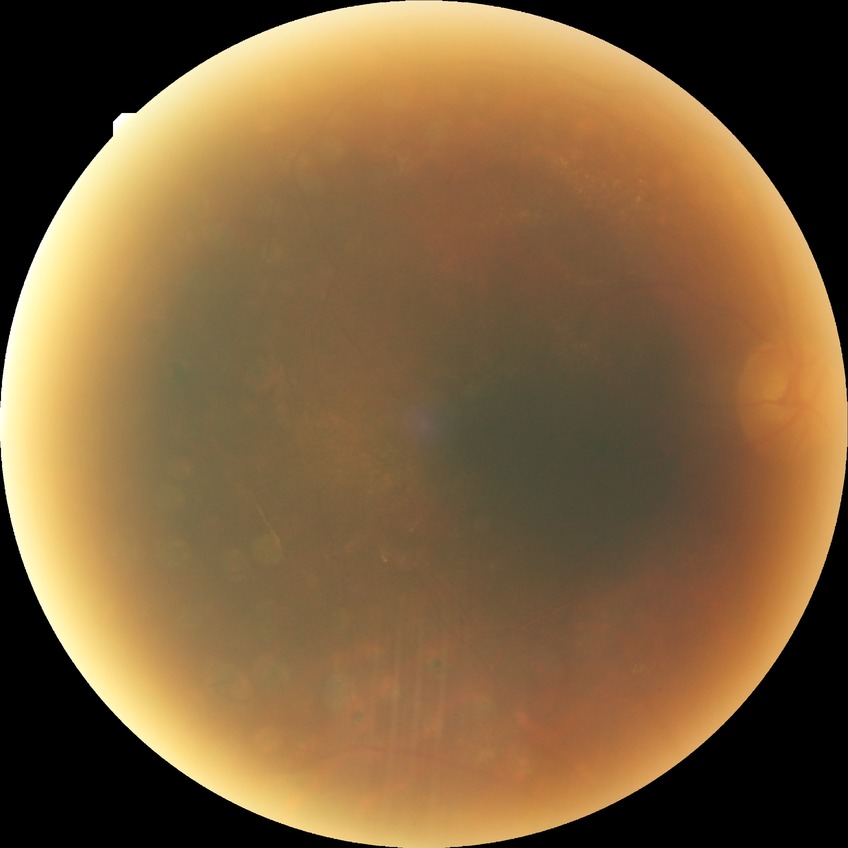

Retinopathy stage: proliferative diabetic retinopathy.